Pediatric retinal photograph (wide-field); 640 by 480 pixels:
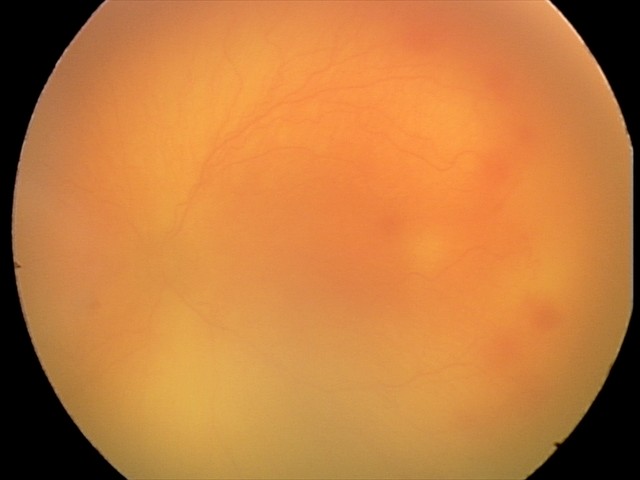

Impression: aggressive retinopathy of prematurity; plus disease.